Color fundus image · 45° FOV · DR severity per modified Davis staging:
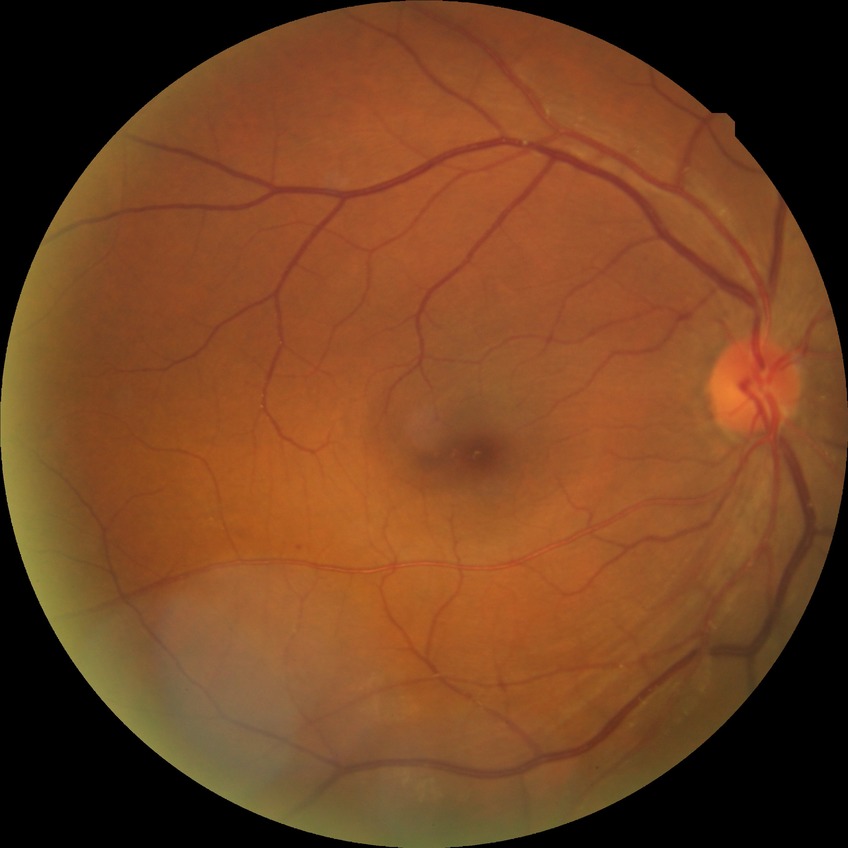
Diabetic retinopathy (DR) is no diabetic retinopathy (NDR).